Captured with the Clarity RetCam 3 (130° field of view); wide-field fundus photograph of an infant; 640x480.
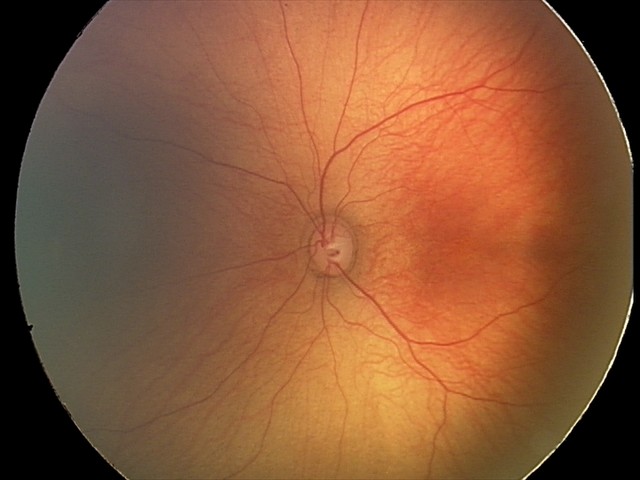

Normal screening examination.